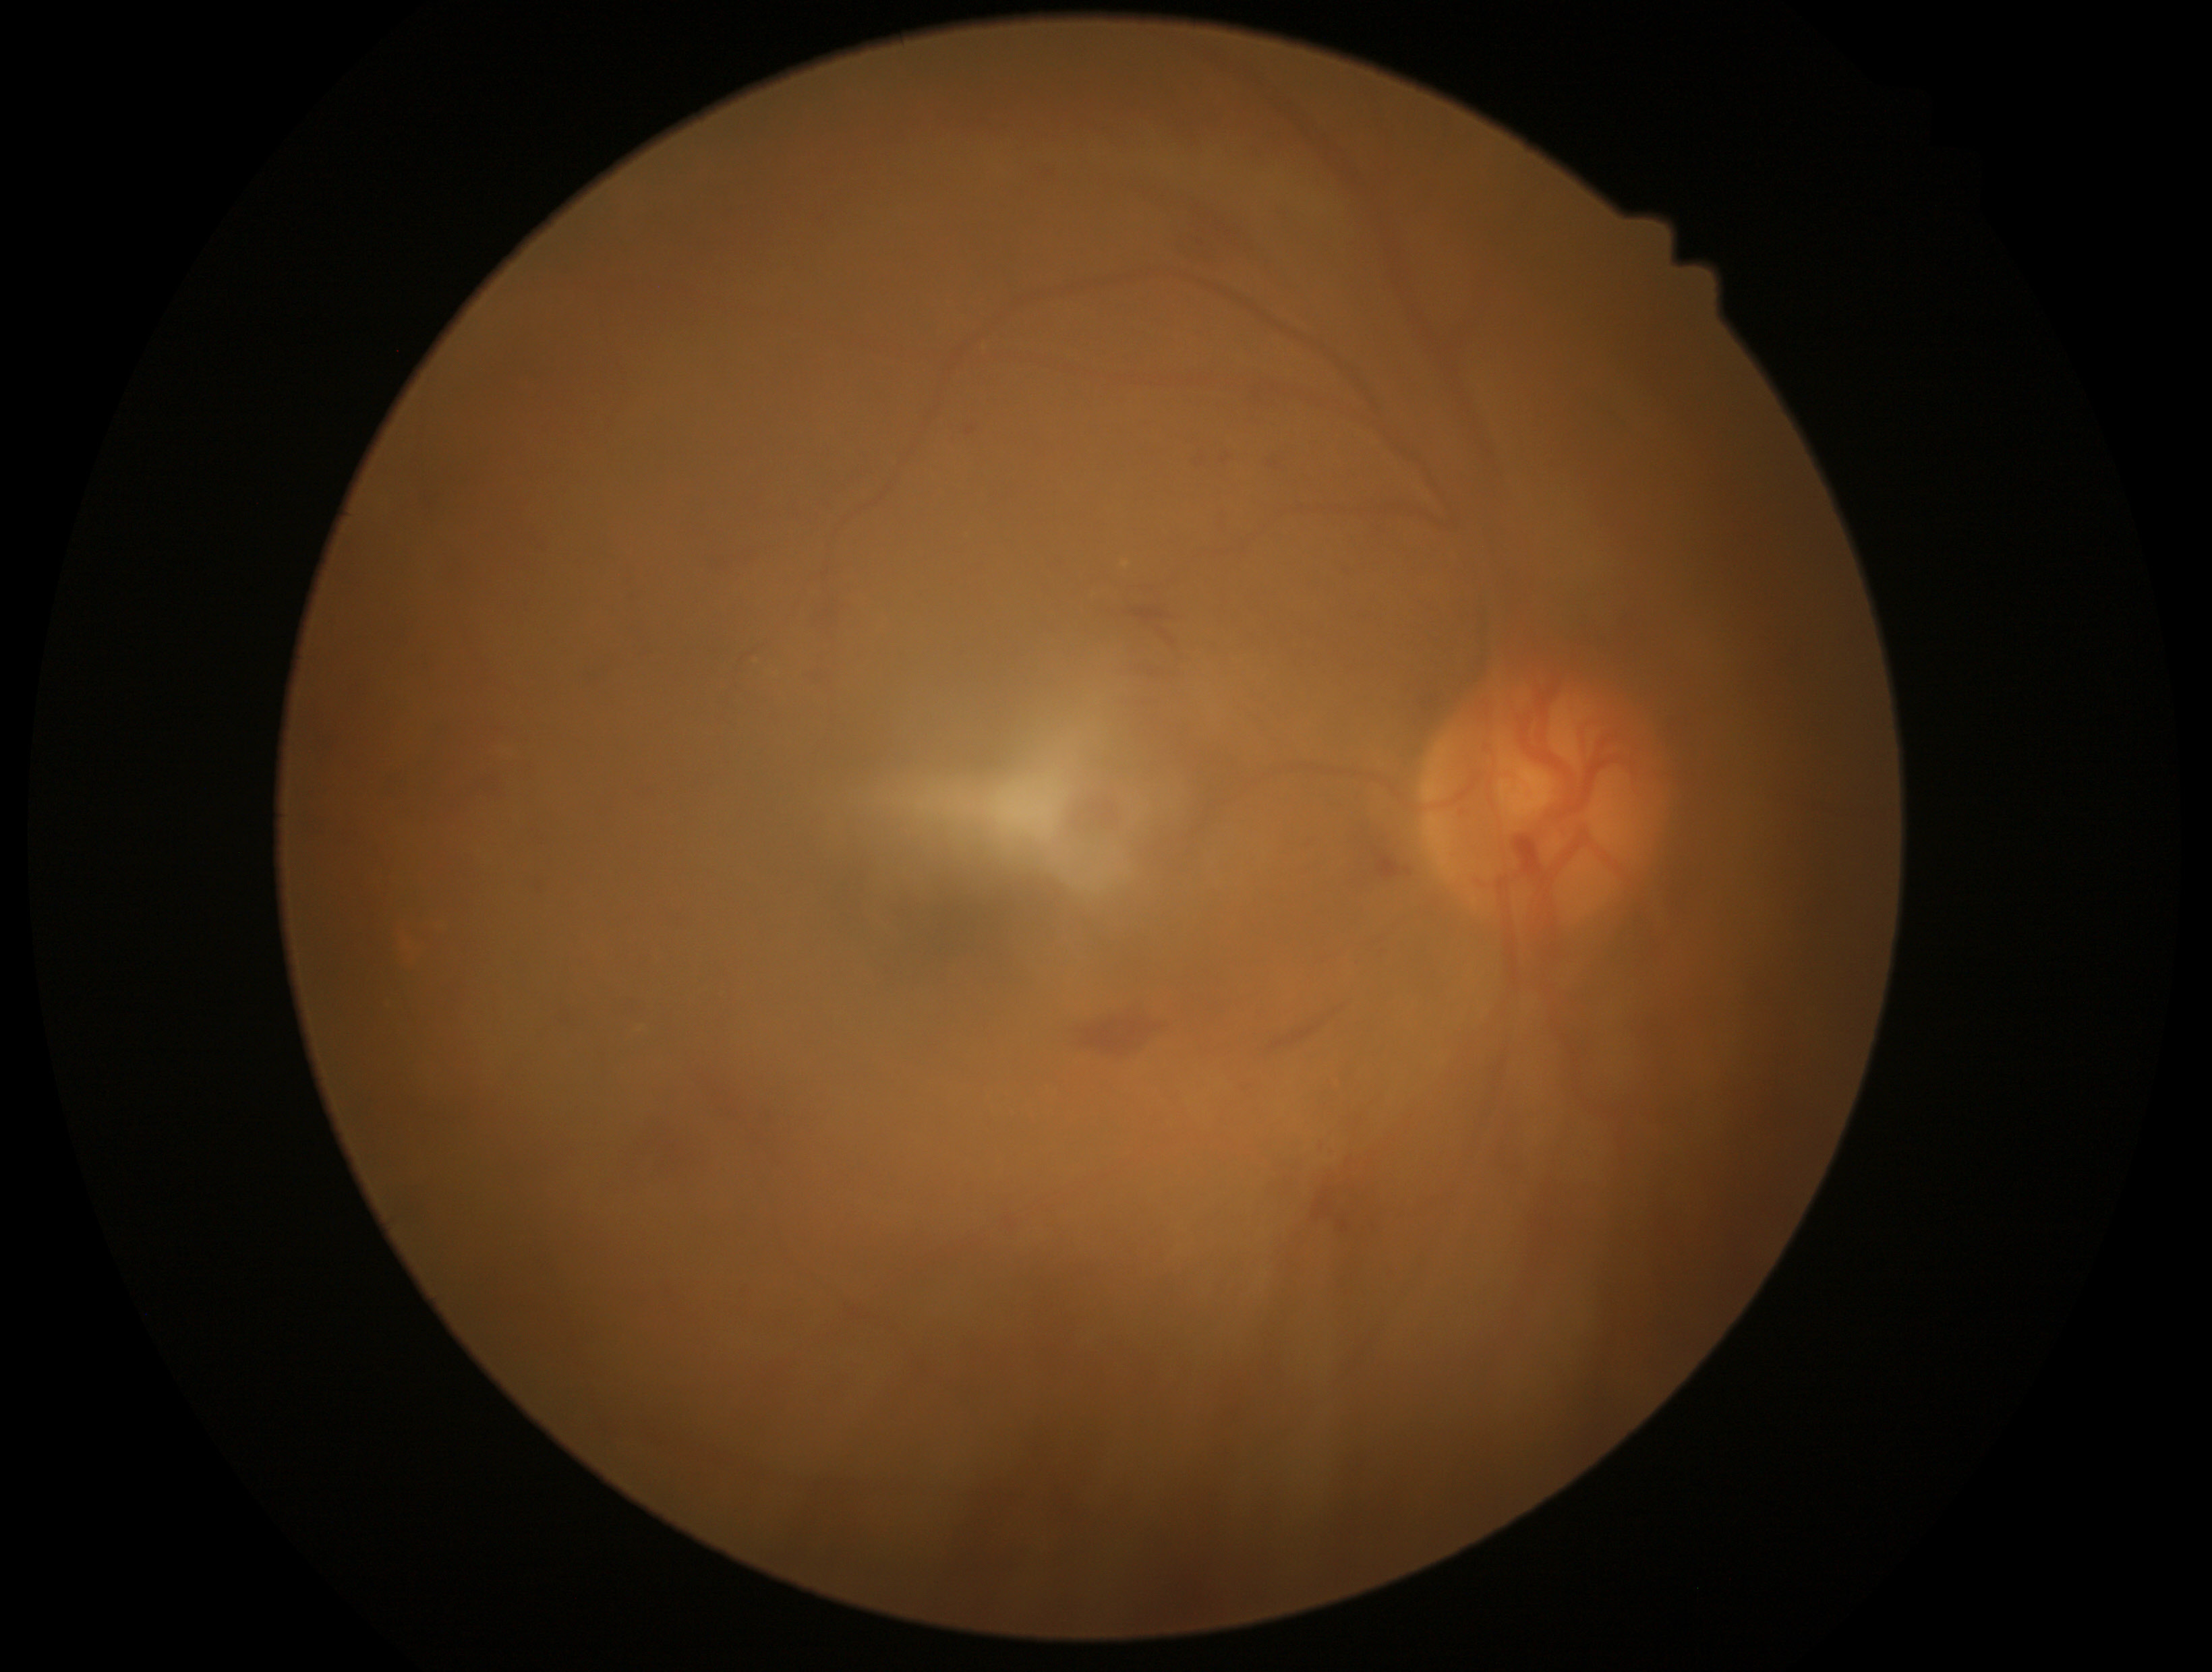 Diabetic retinopathy (DR) is grade 2 (moderate NPDR).